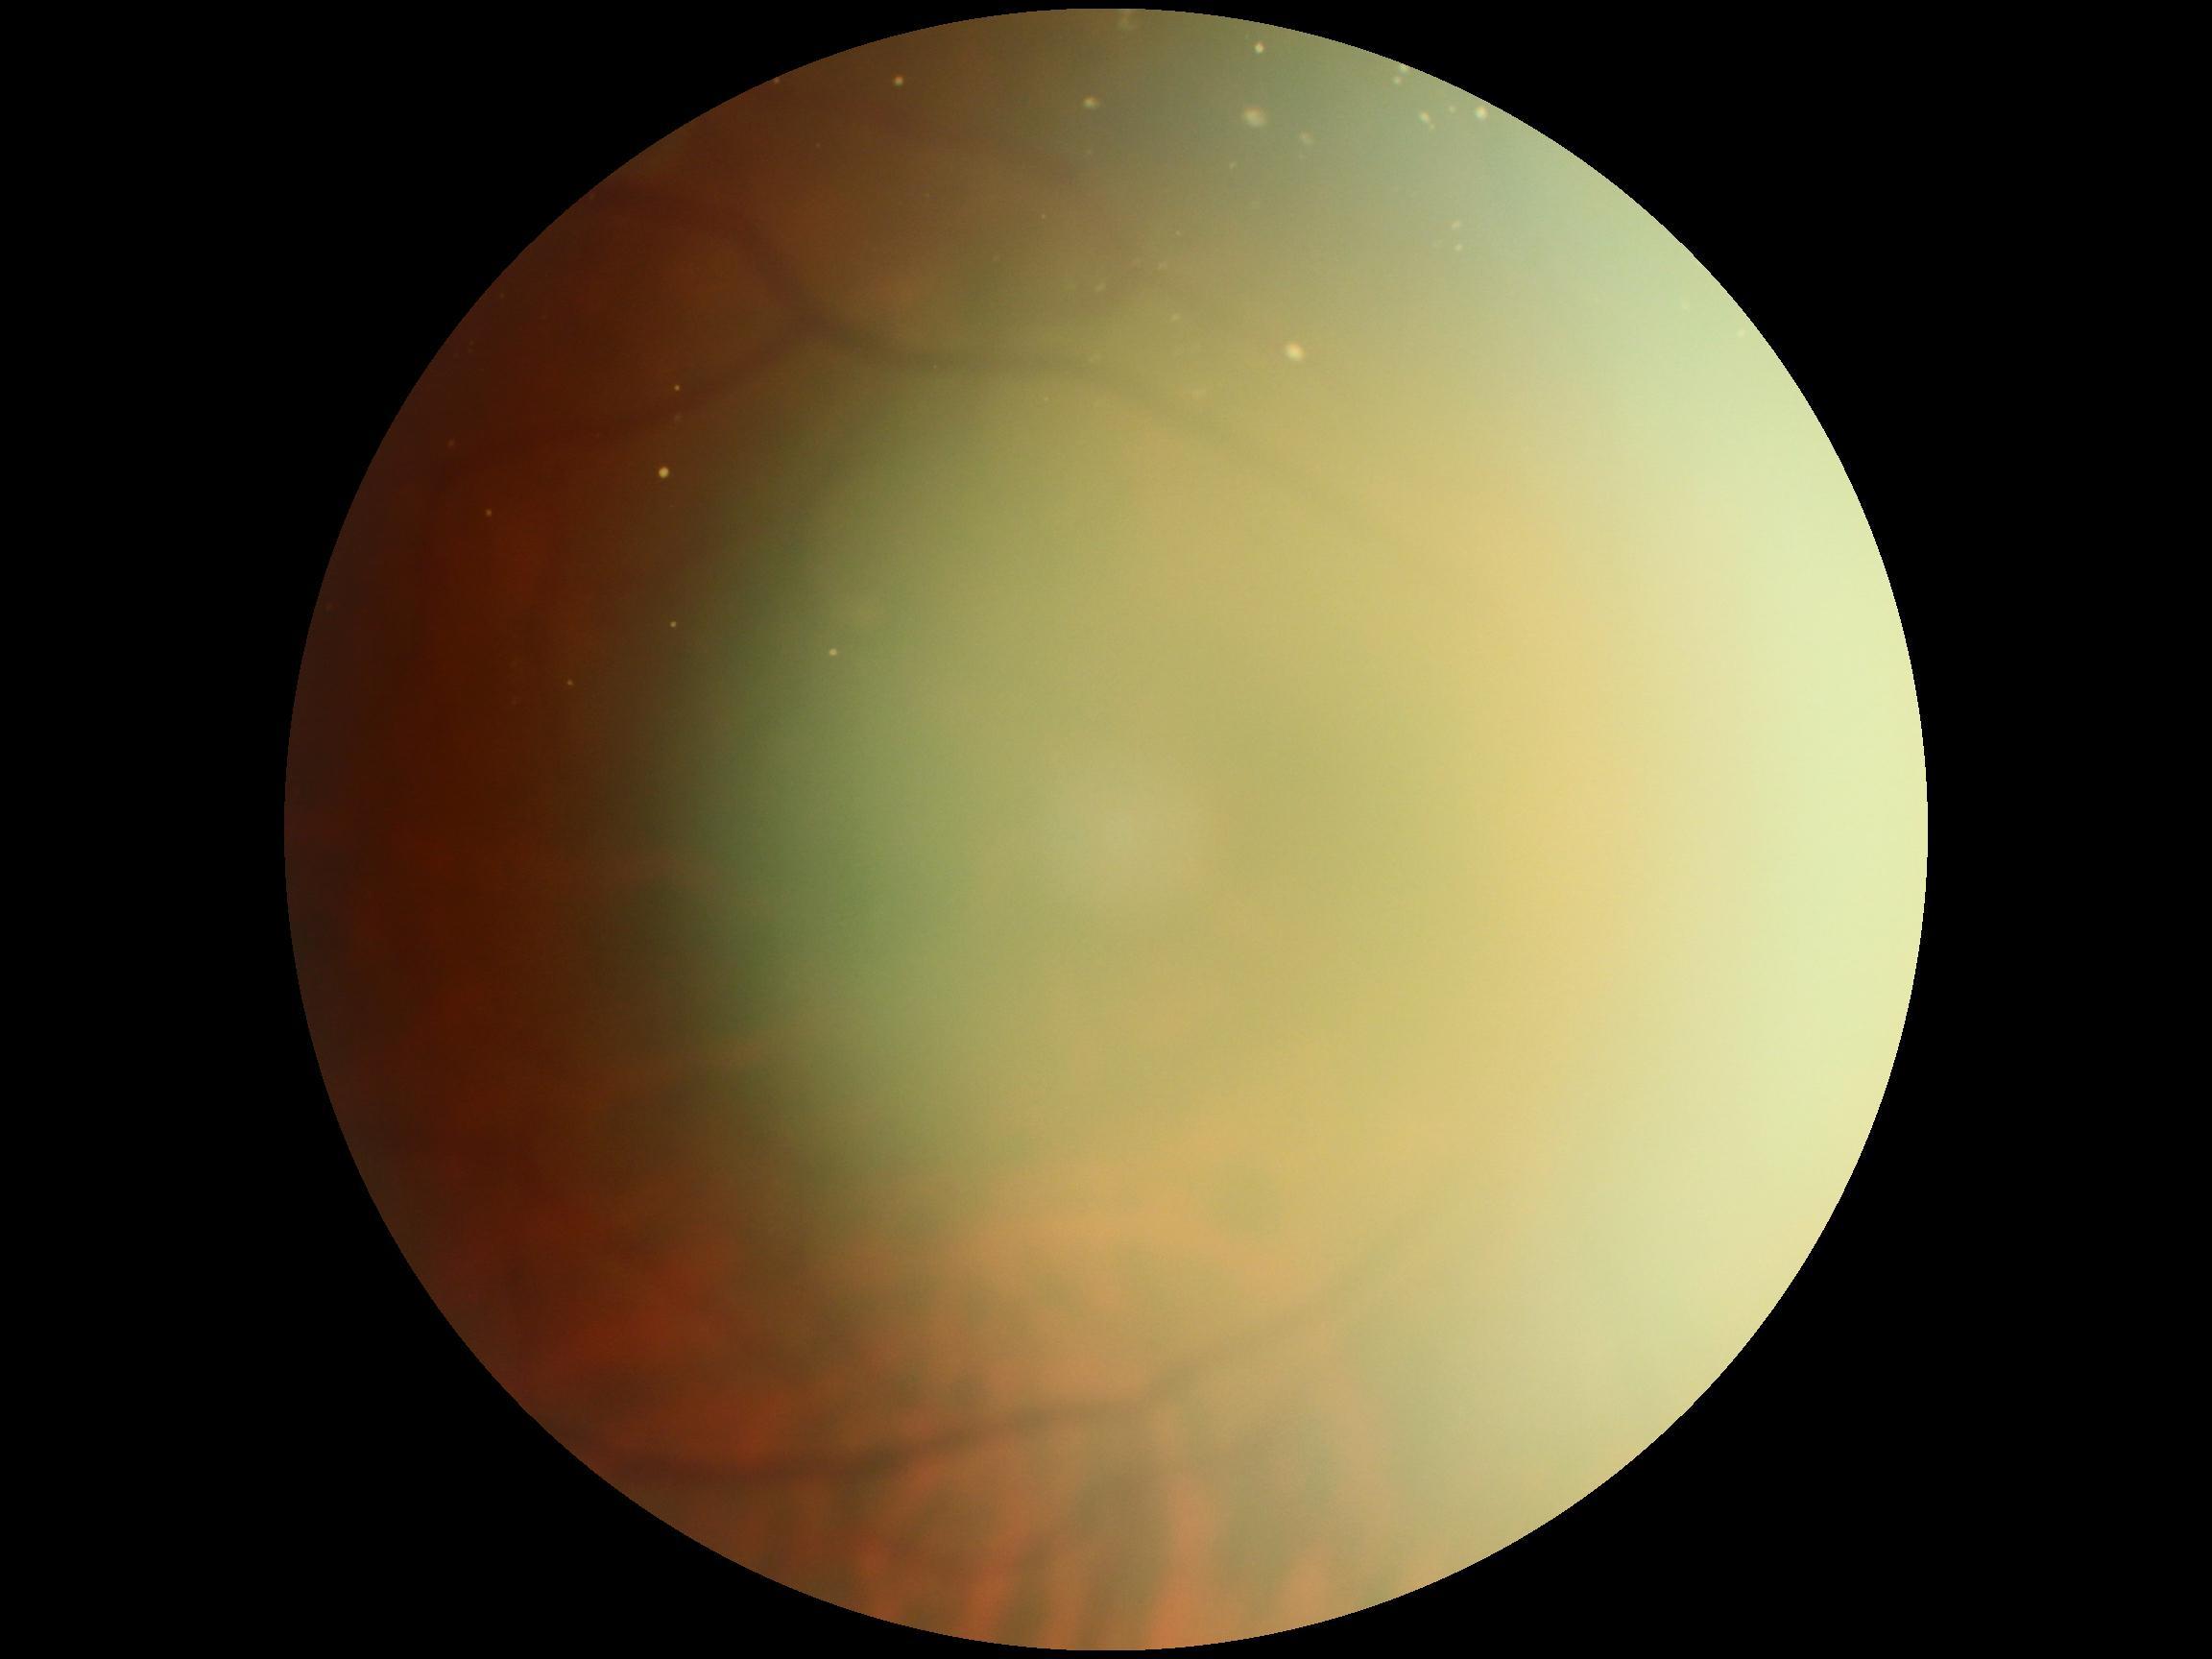 Quality too poor to assess for DR.
Diabetic retinopathy (DR): ungradable.